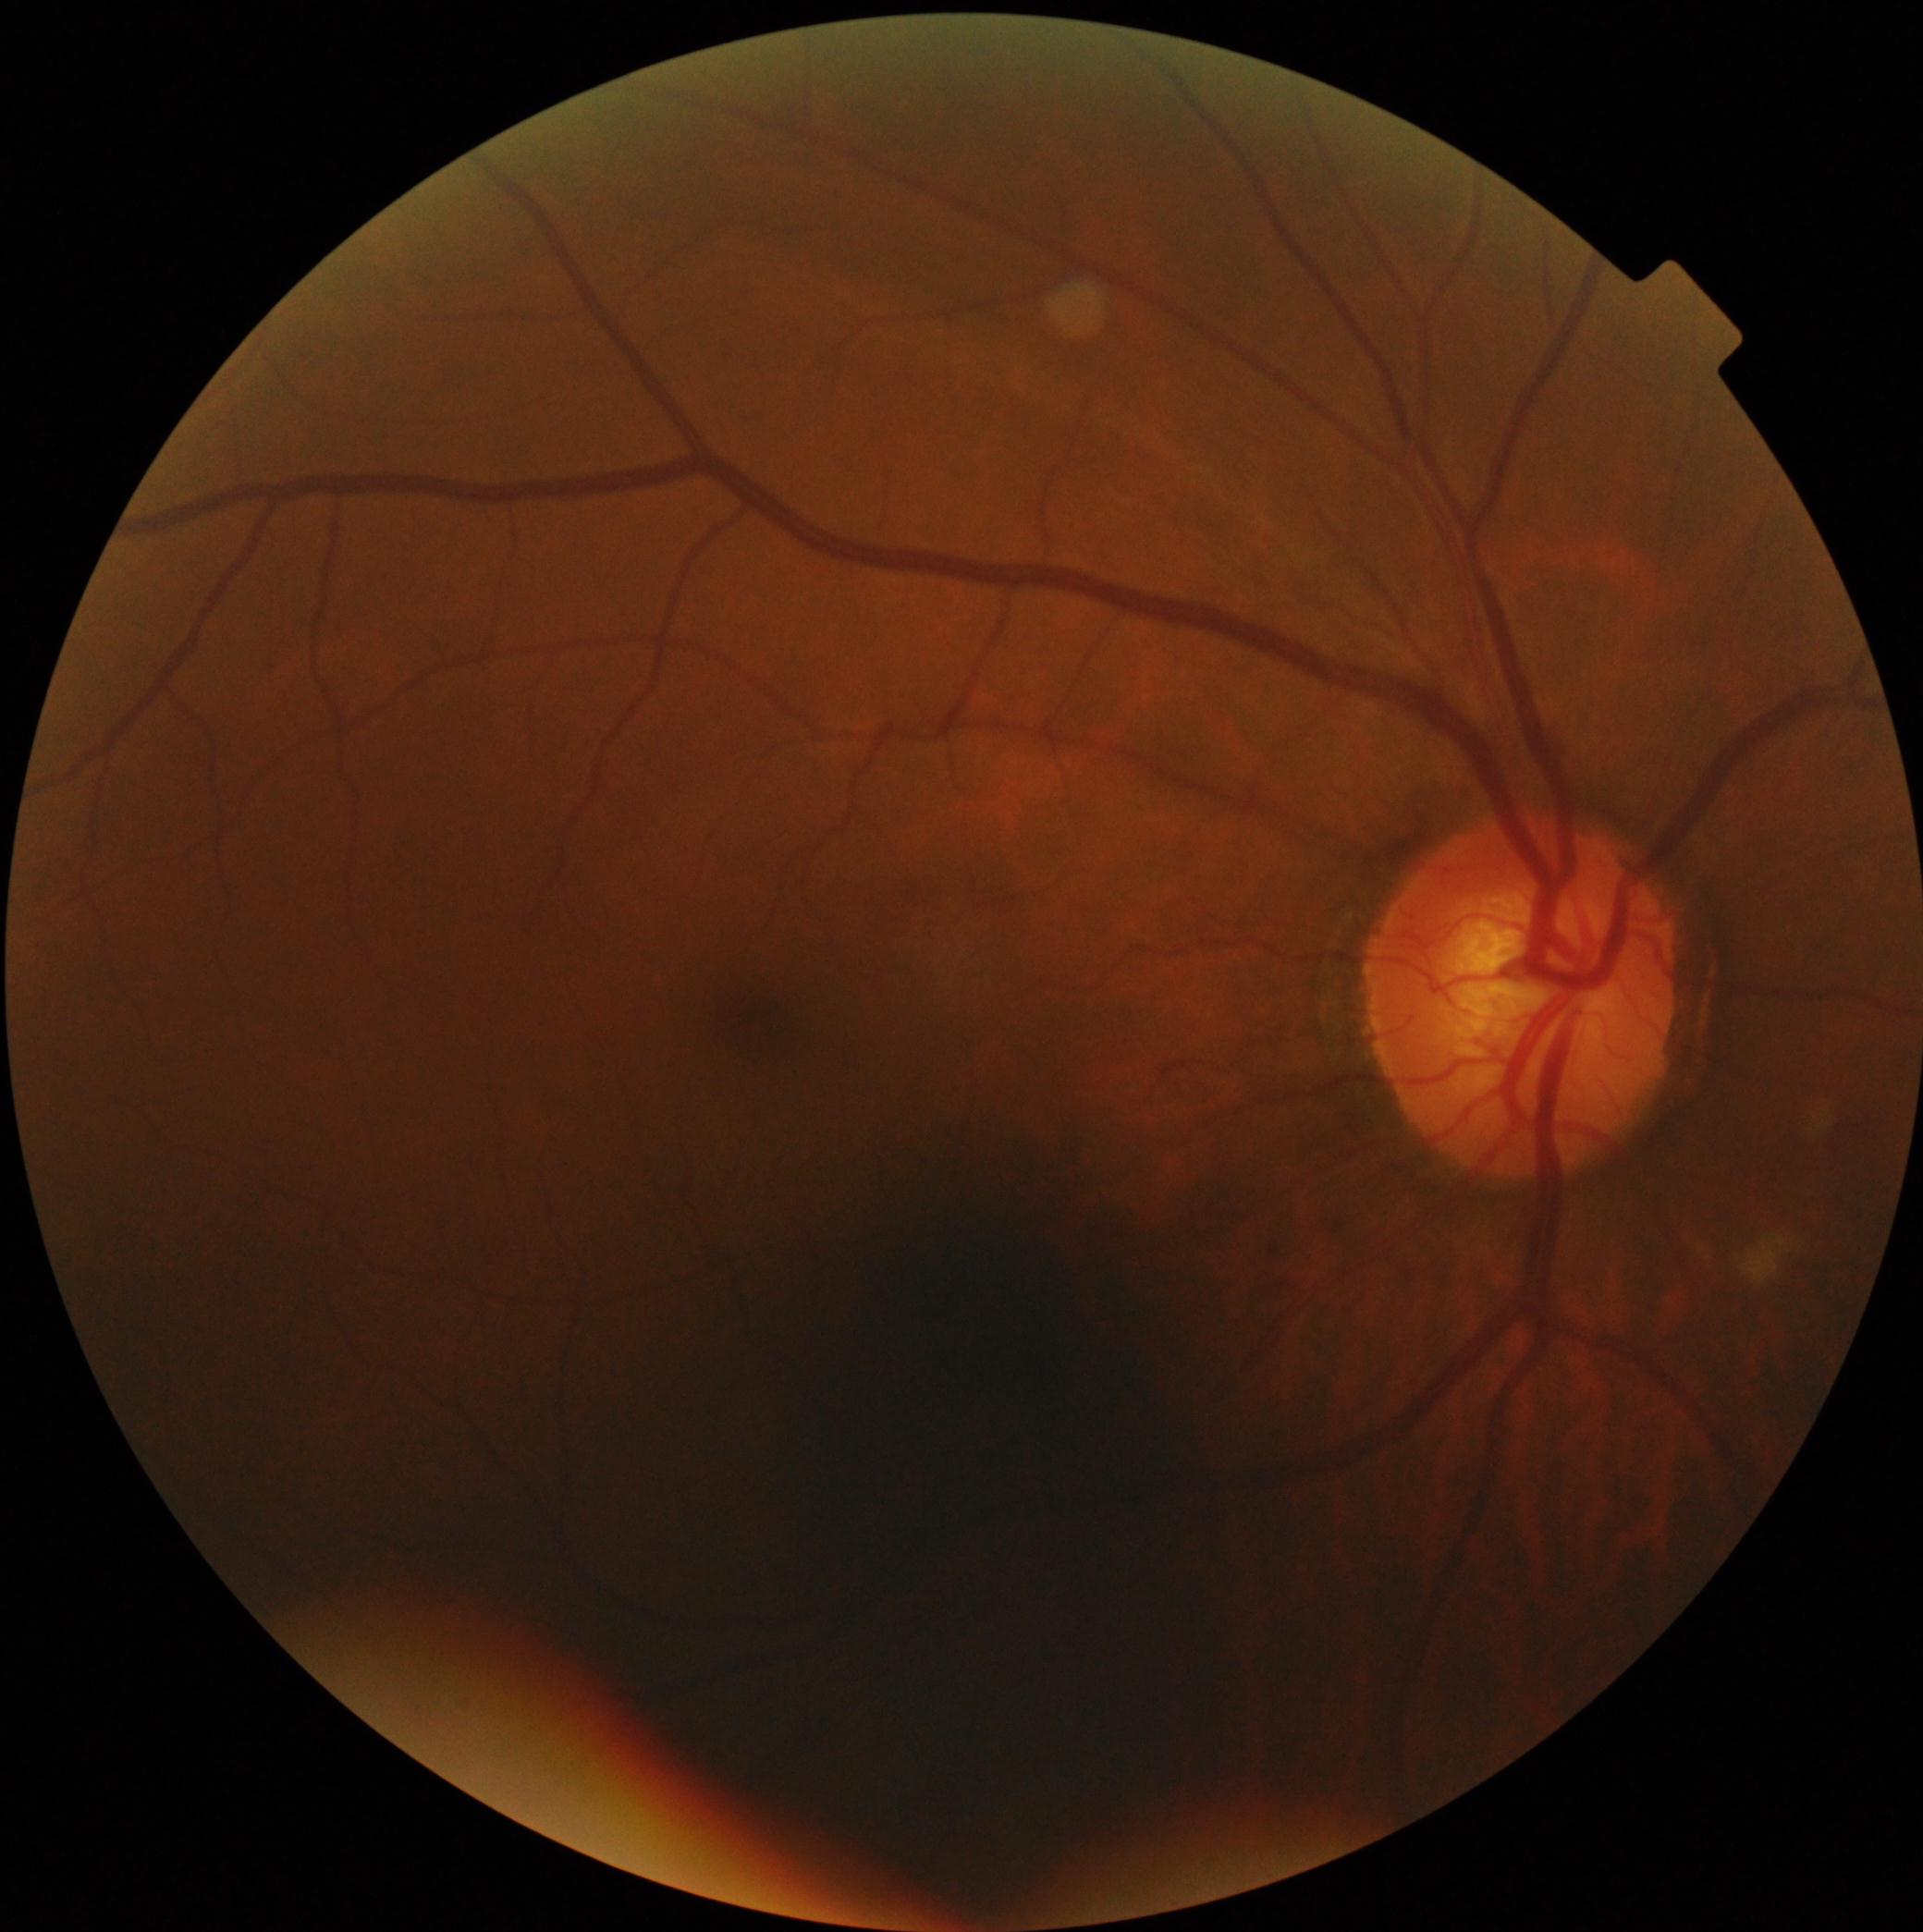

diabetic retinopathy (DR): no apparent retinopathy (grade 0) — no visible signs of diabetic retinopathy.